2048 by 1536 pixels: 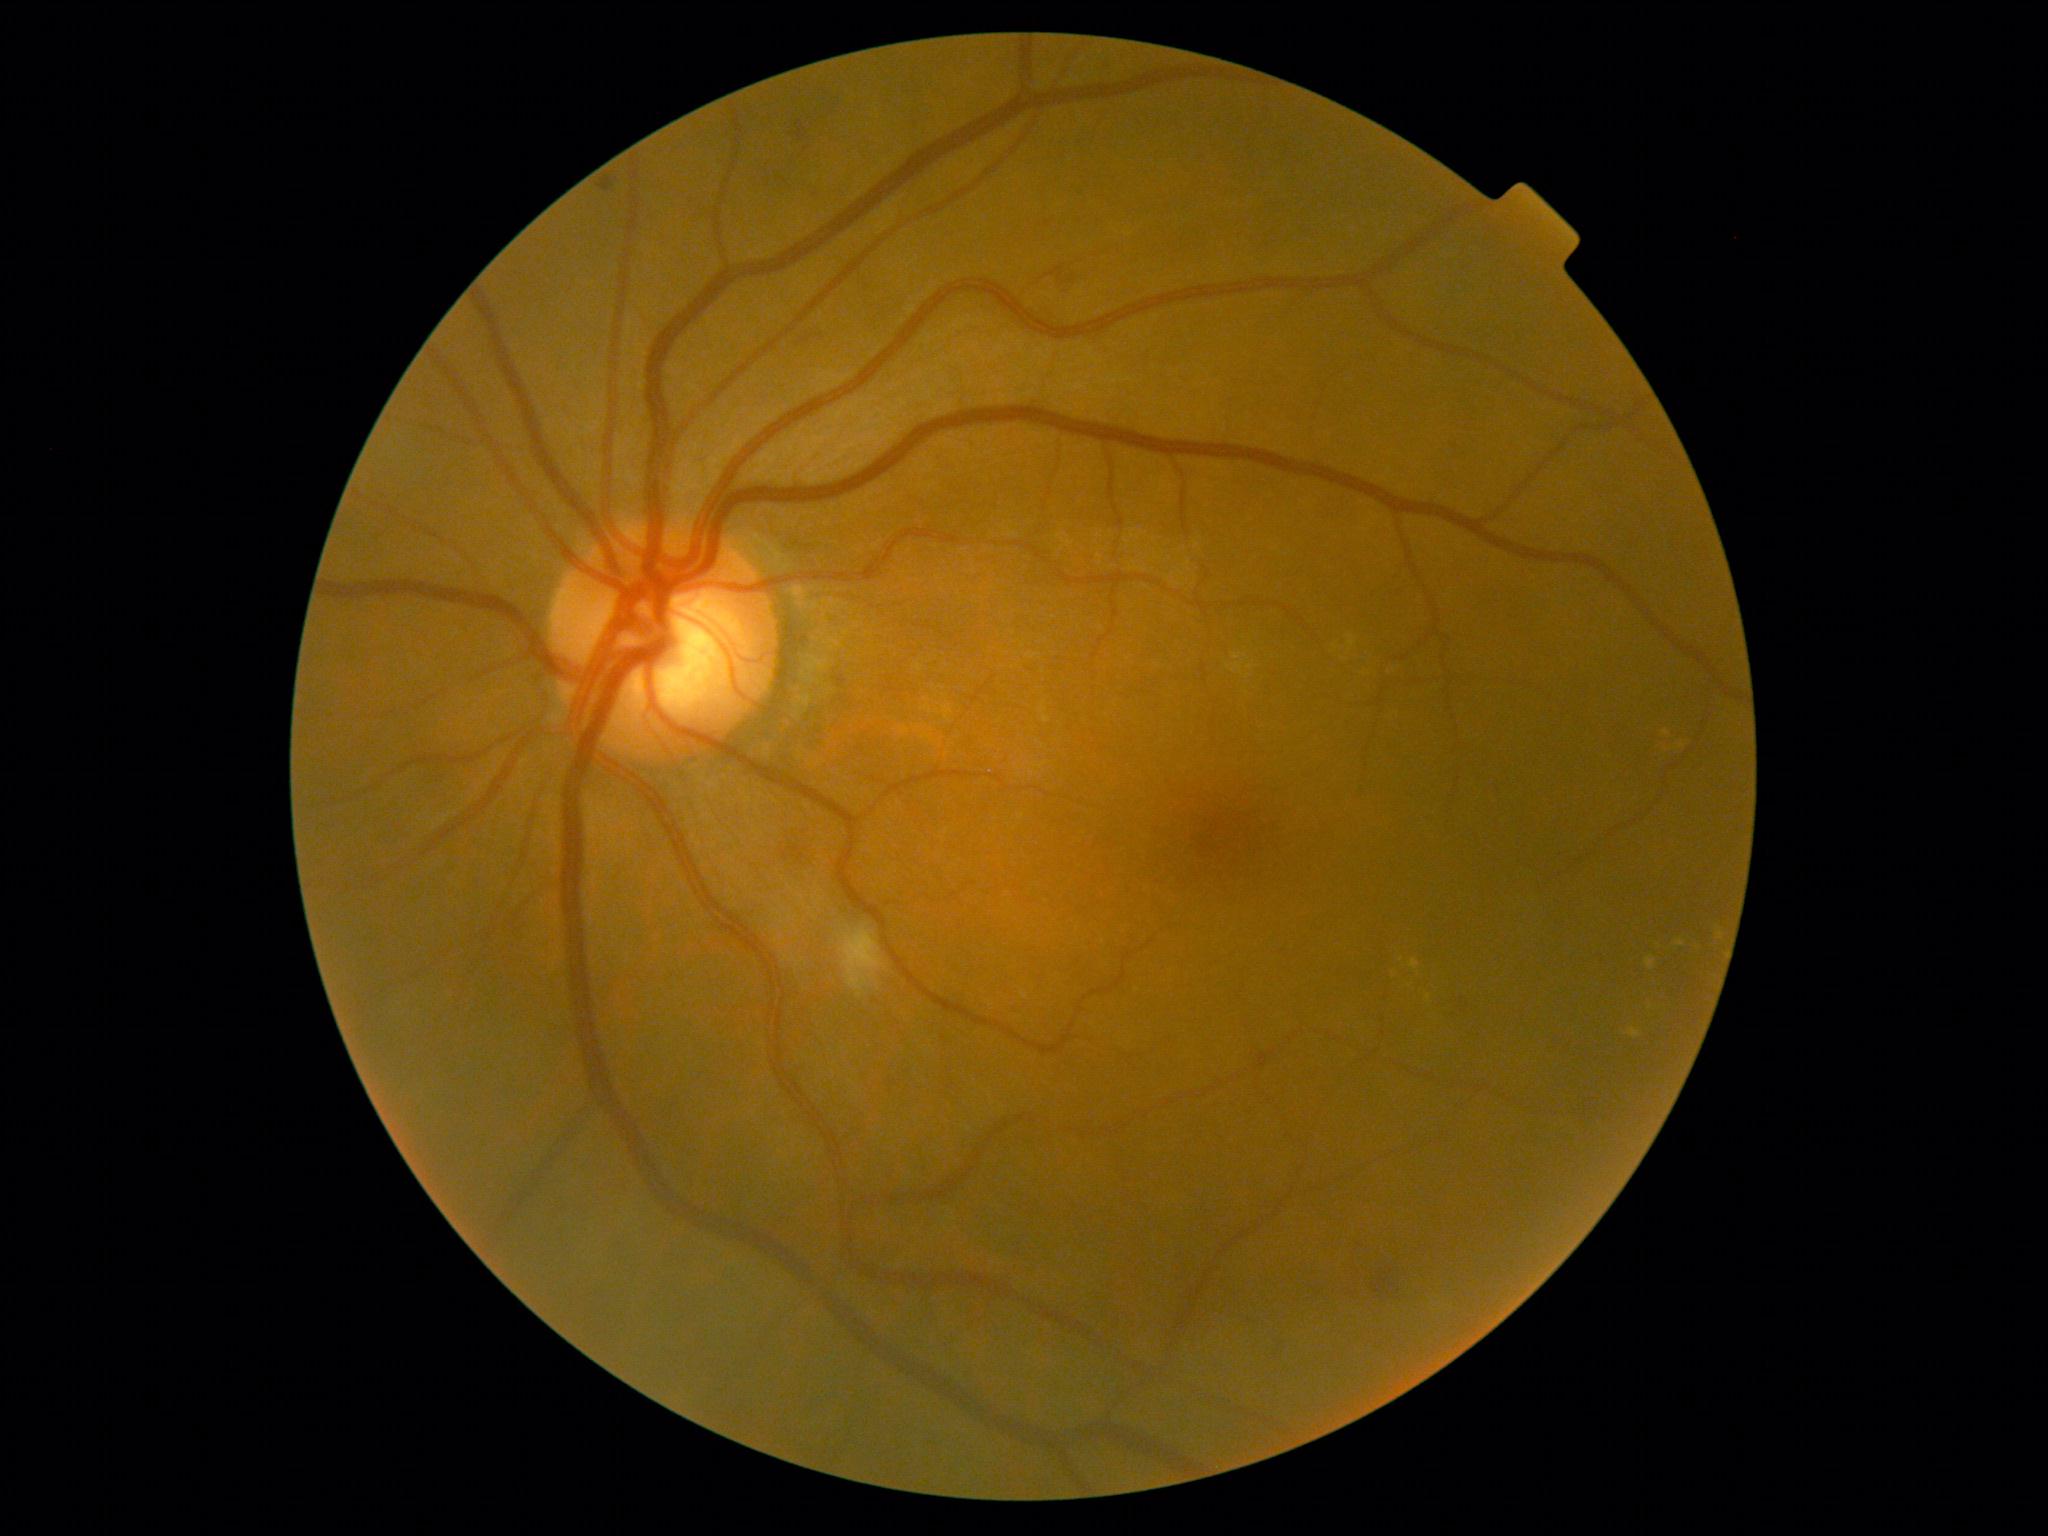

DR: grade 2 (moderate NPDR).